1725 by 1721 pixels — 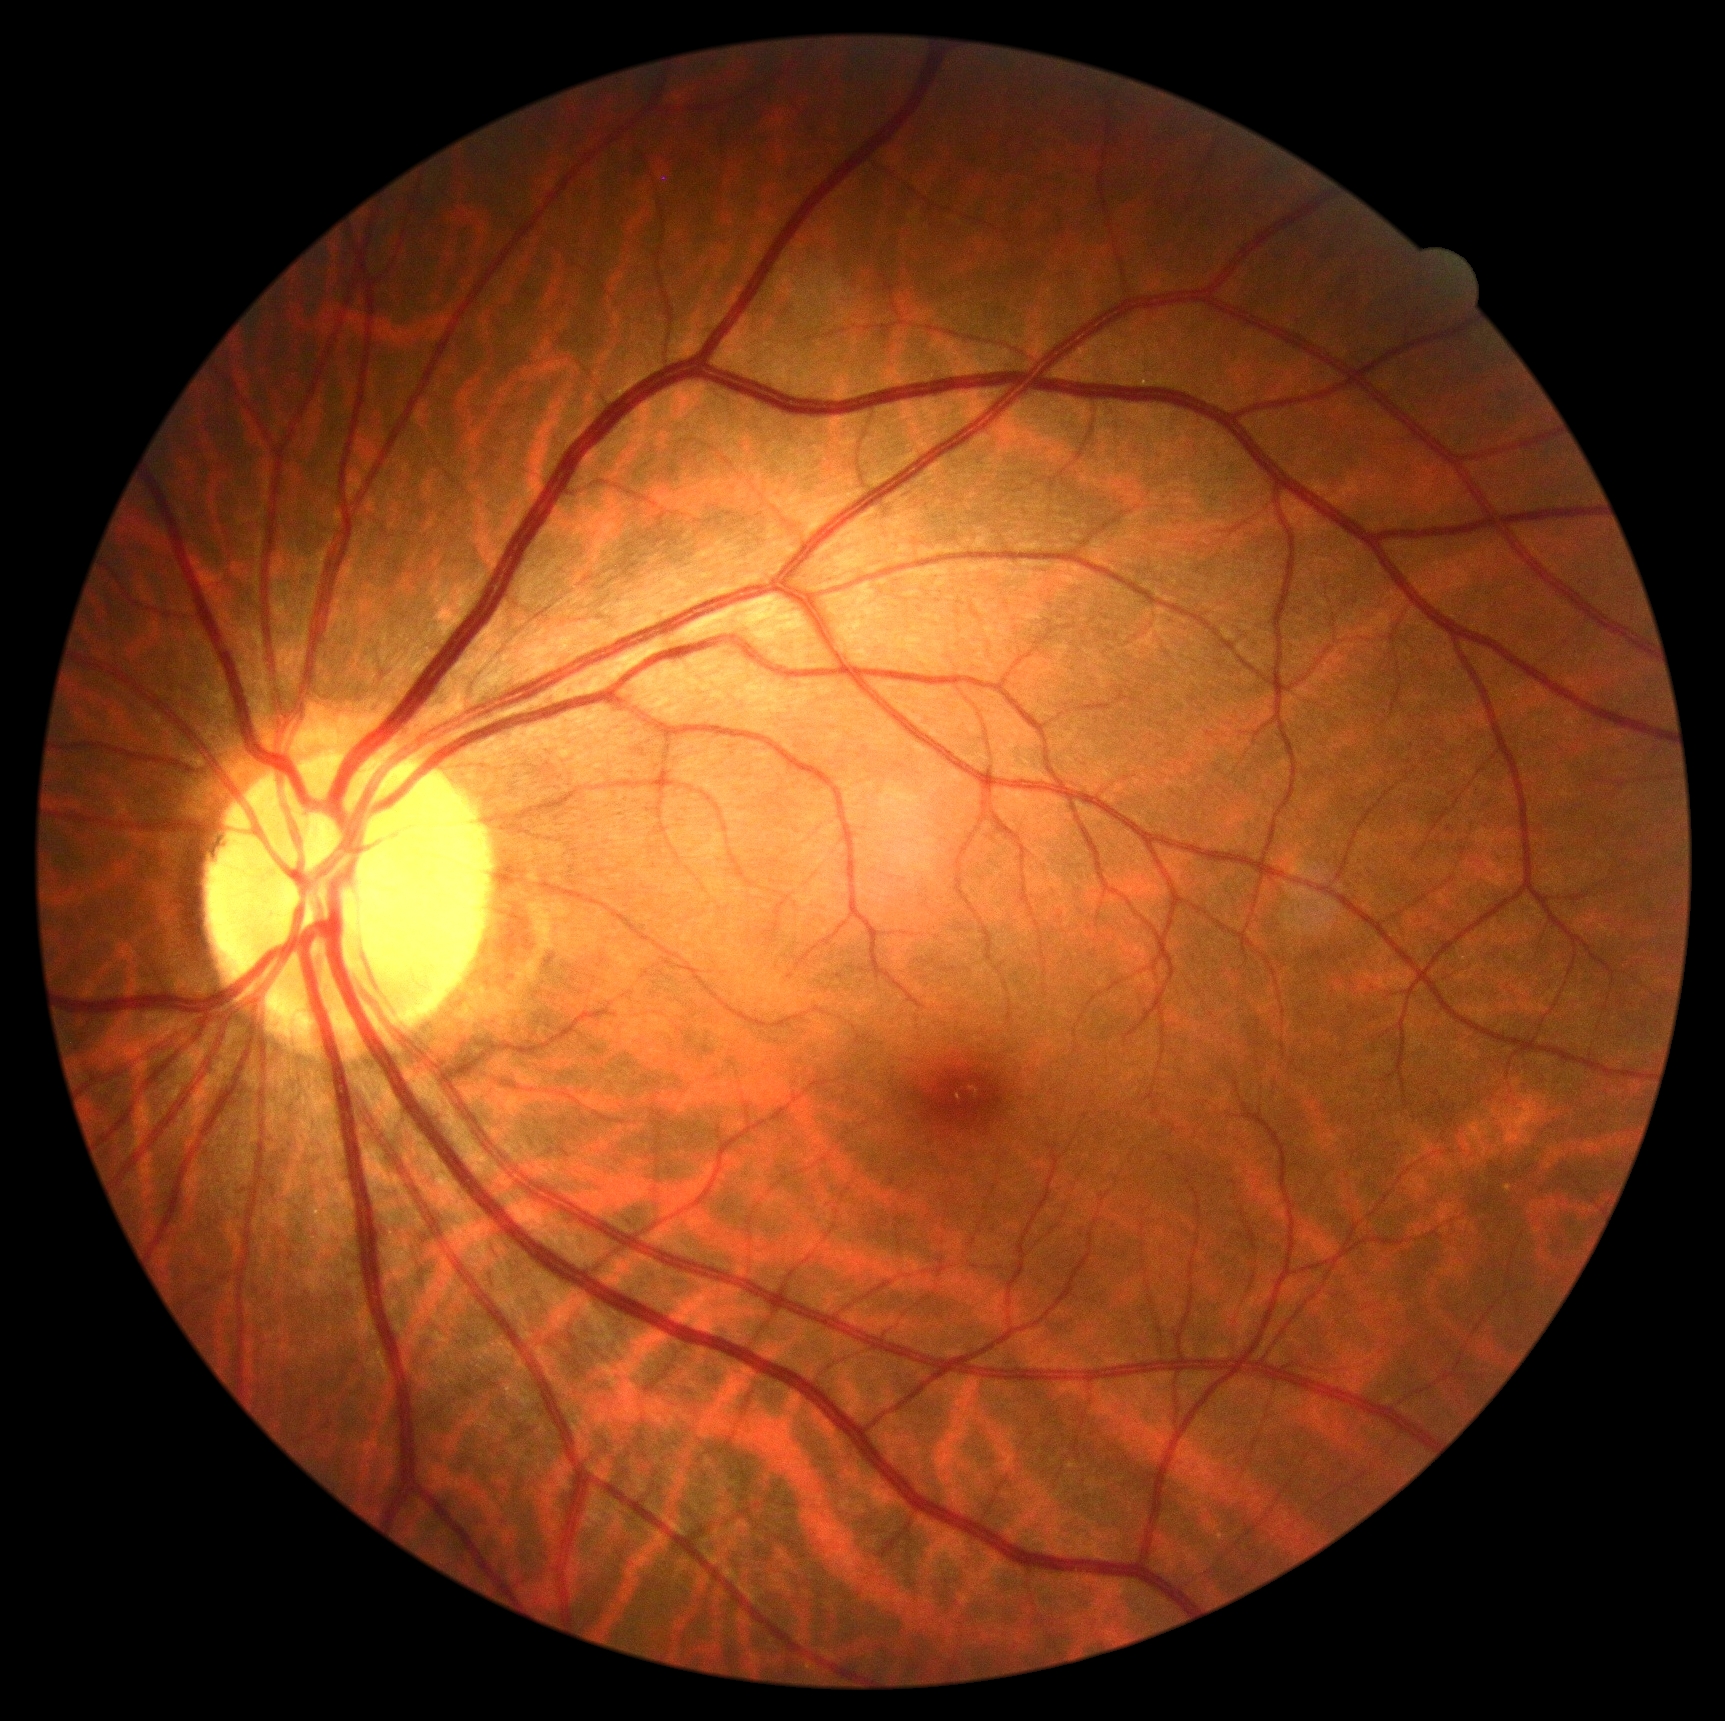
No DR findings.
DR stage: no apparent retinopathy (grade 0).